Color fundus image. Diabetic retinopathy graded by the modified Davis classification — 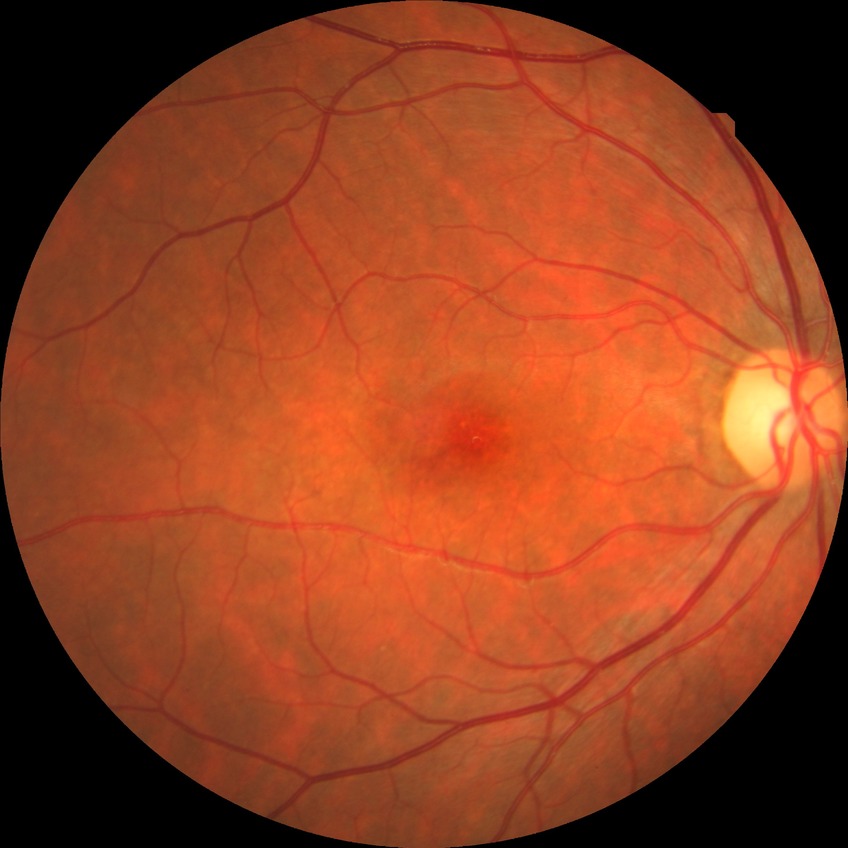 Diabetic retinopathy stage: no diabetic retinopathy.